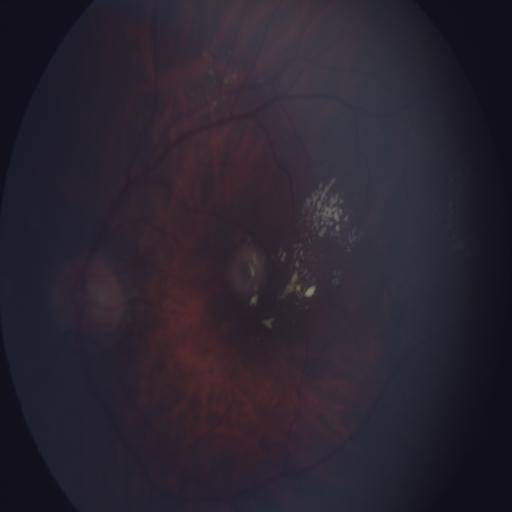
Two findings. Color fundus photograph showing exudation and hemorrhagic retinopathy.